45° FOV; 2048 by 1536 pixels; retinal fundus photograph: 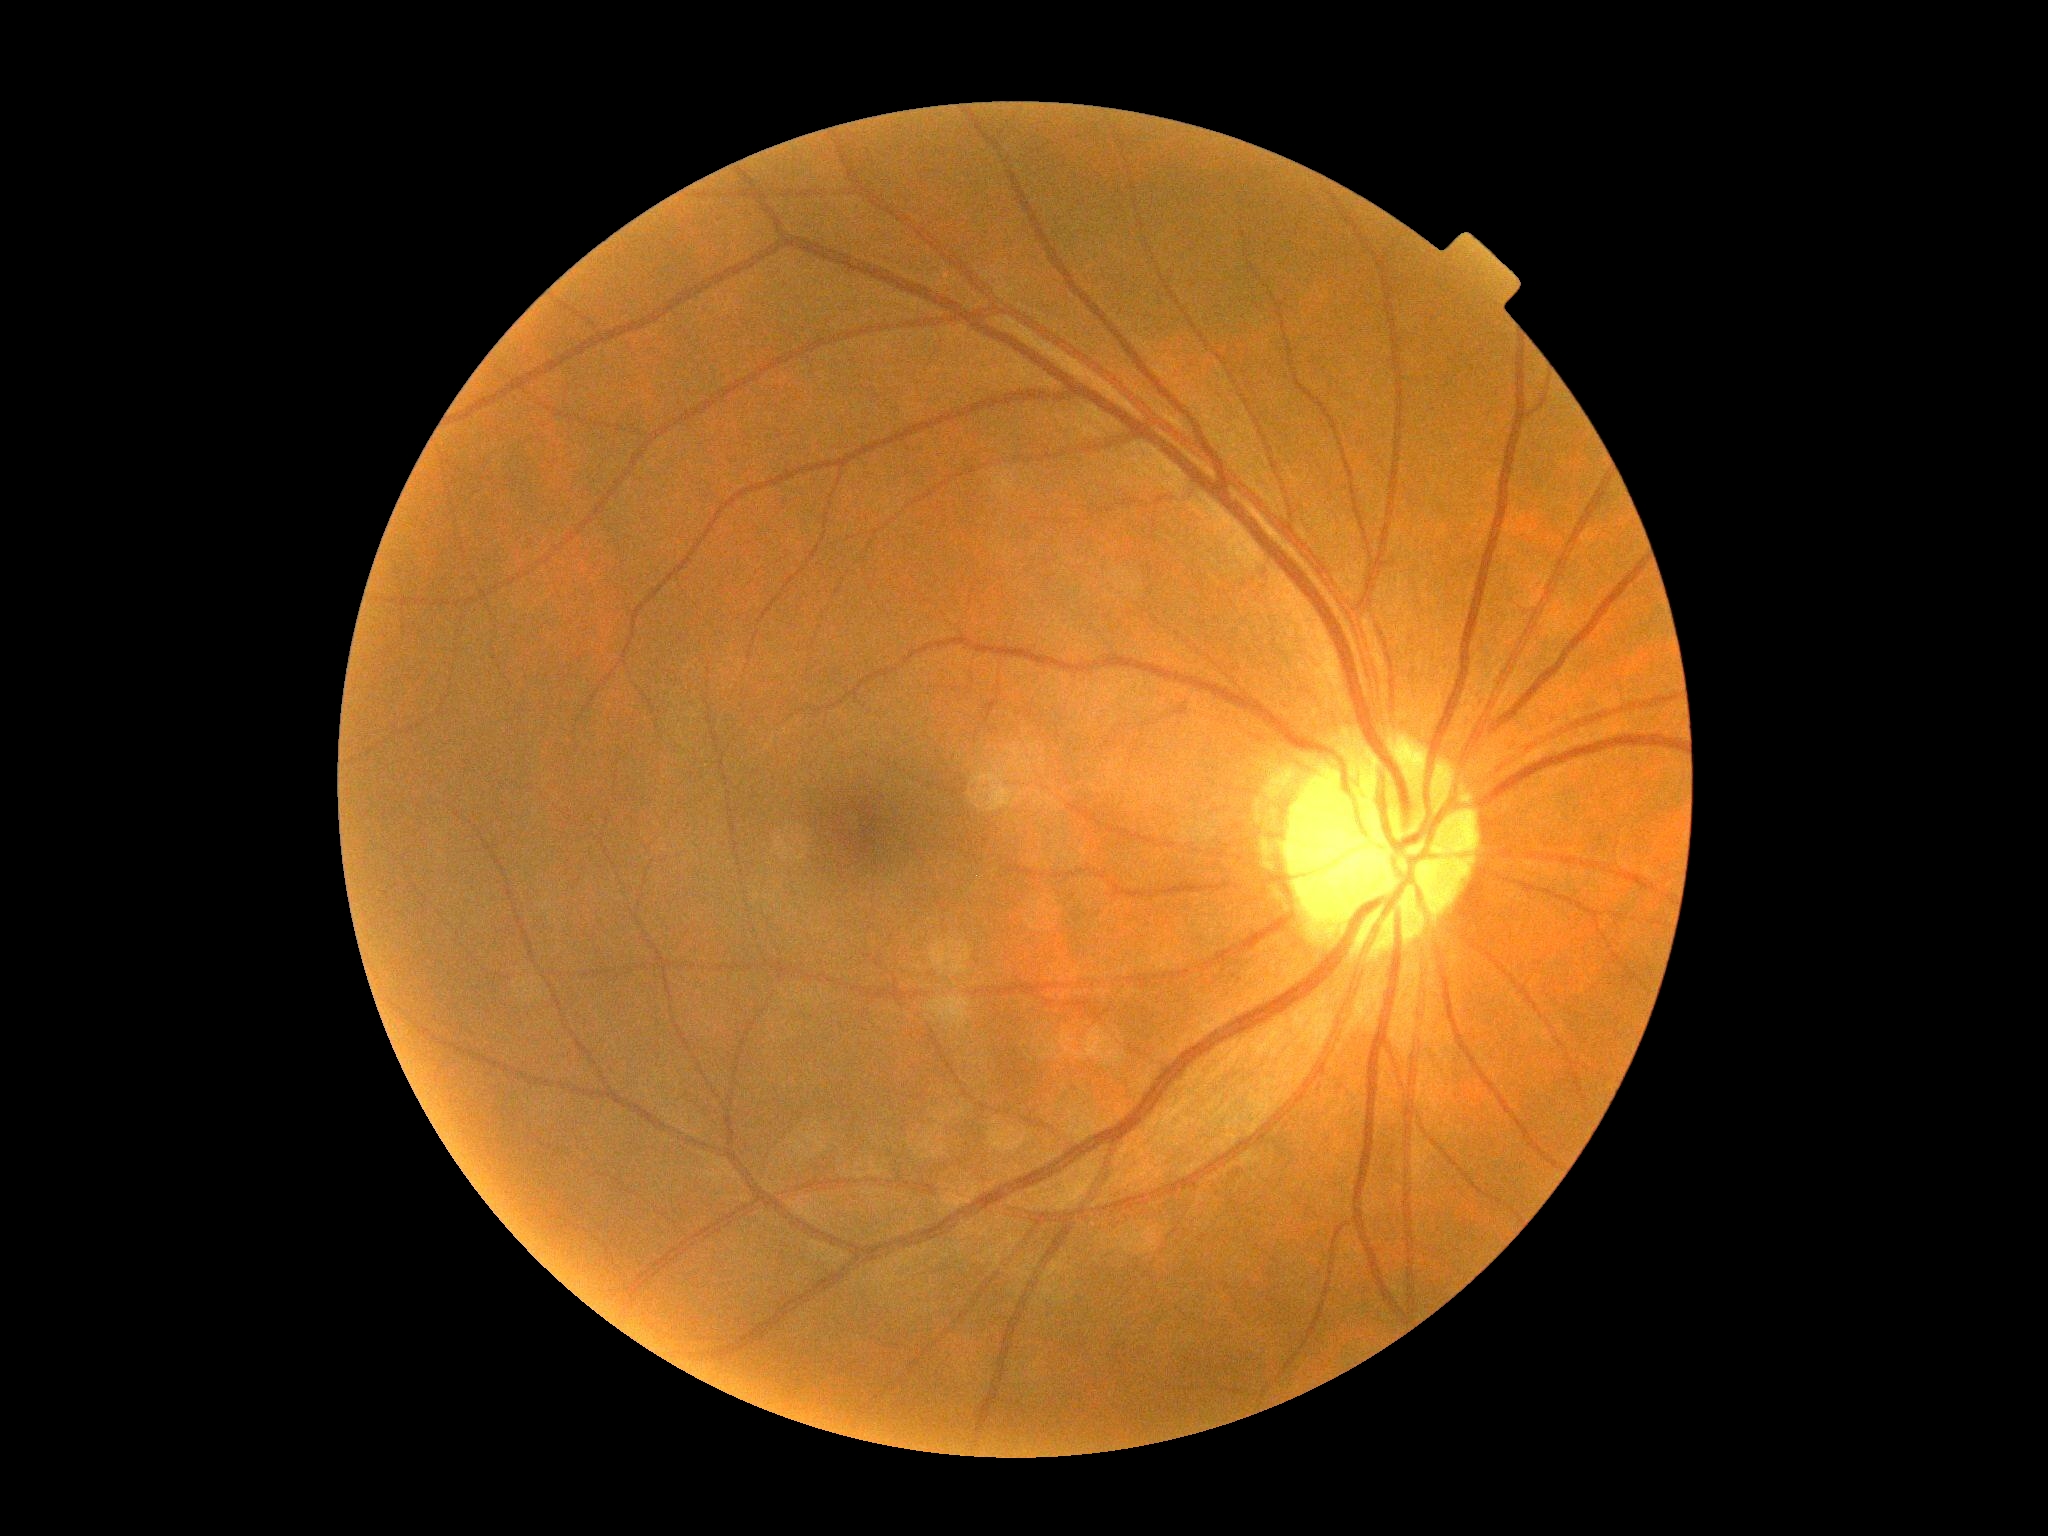 Diabetic retinopathy (DR) is grade 0 (no apparent retinopathy) — no visible signs of diabetic retinopathy.